Fundus photo. Topcon TRC-NW400. Axial length (AL): 22.77 mm
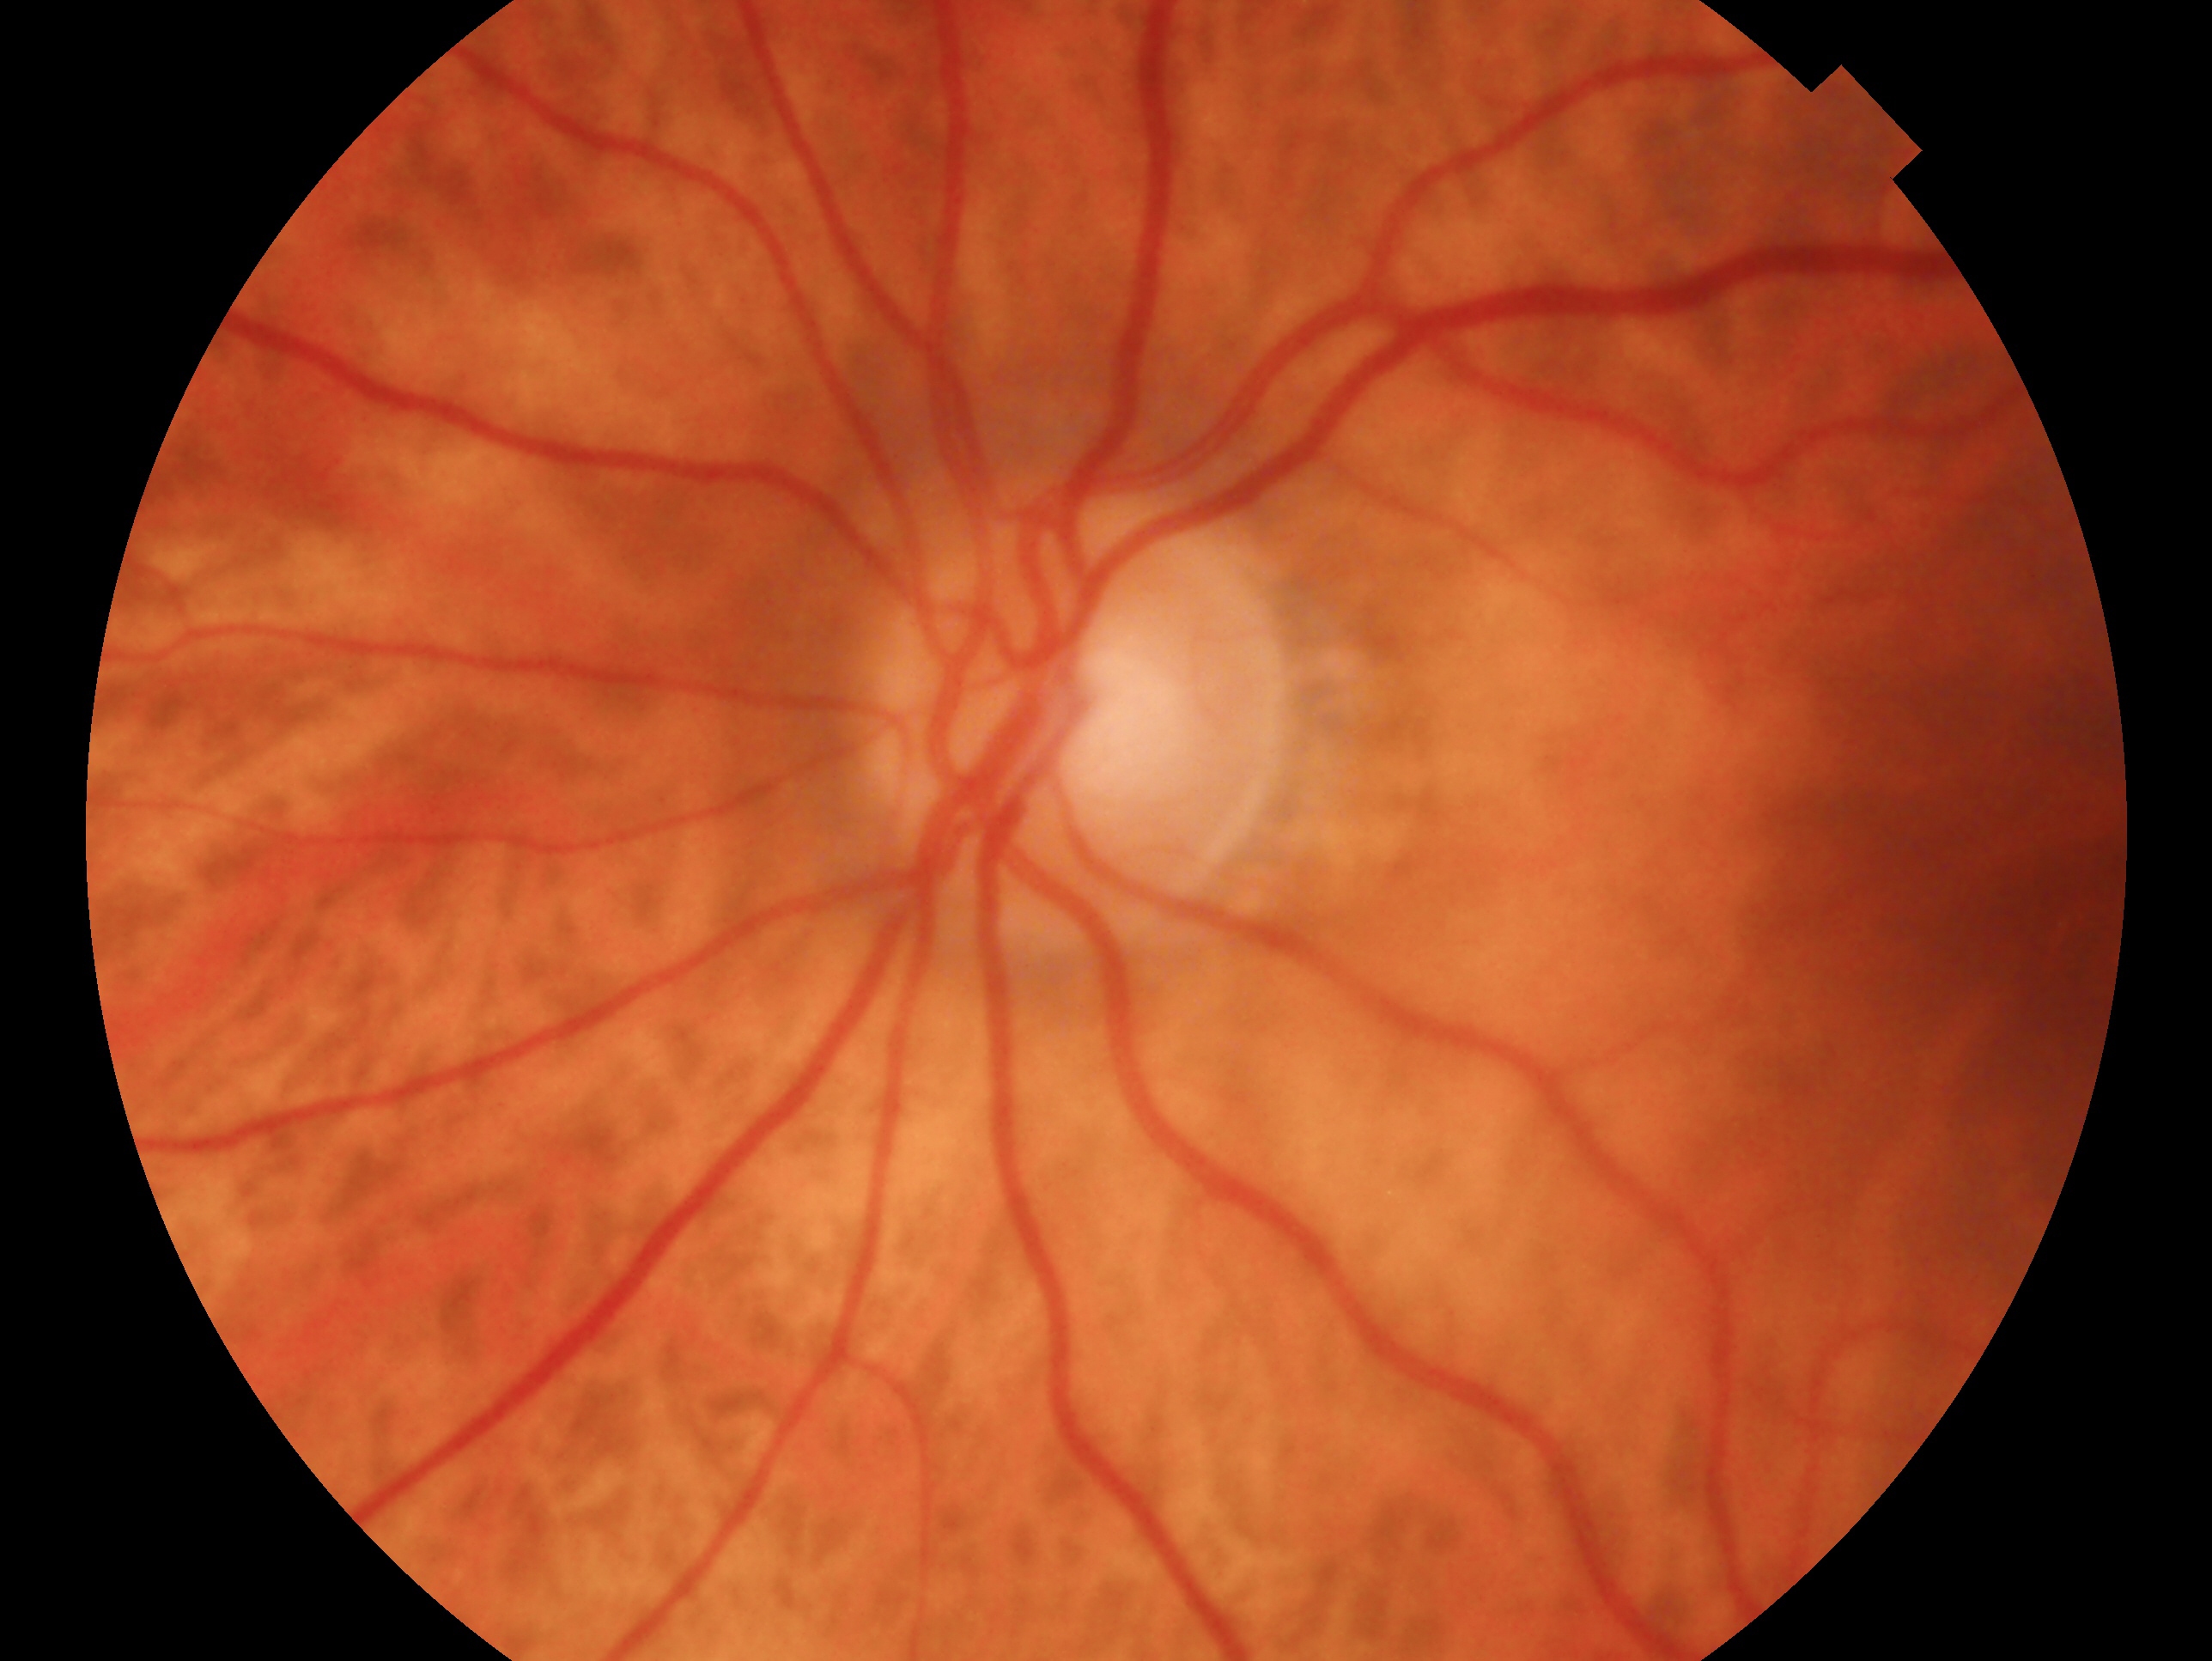
eye: OS
impression: no glaucomatous findings